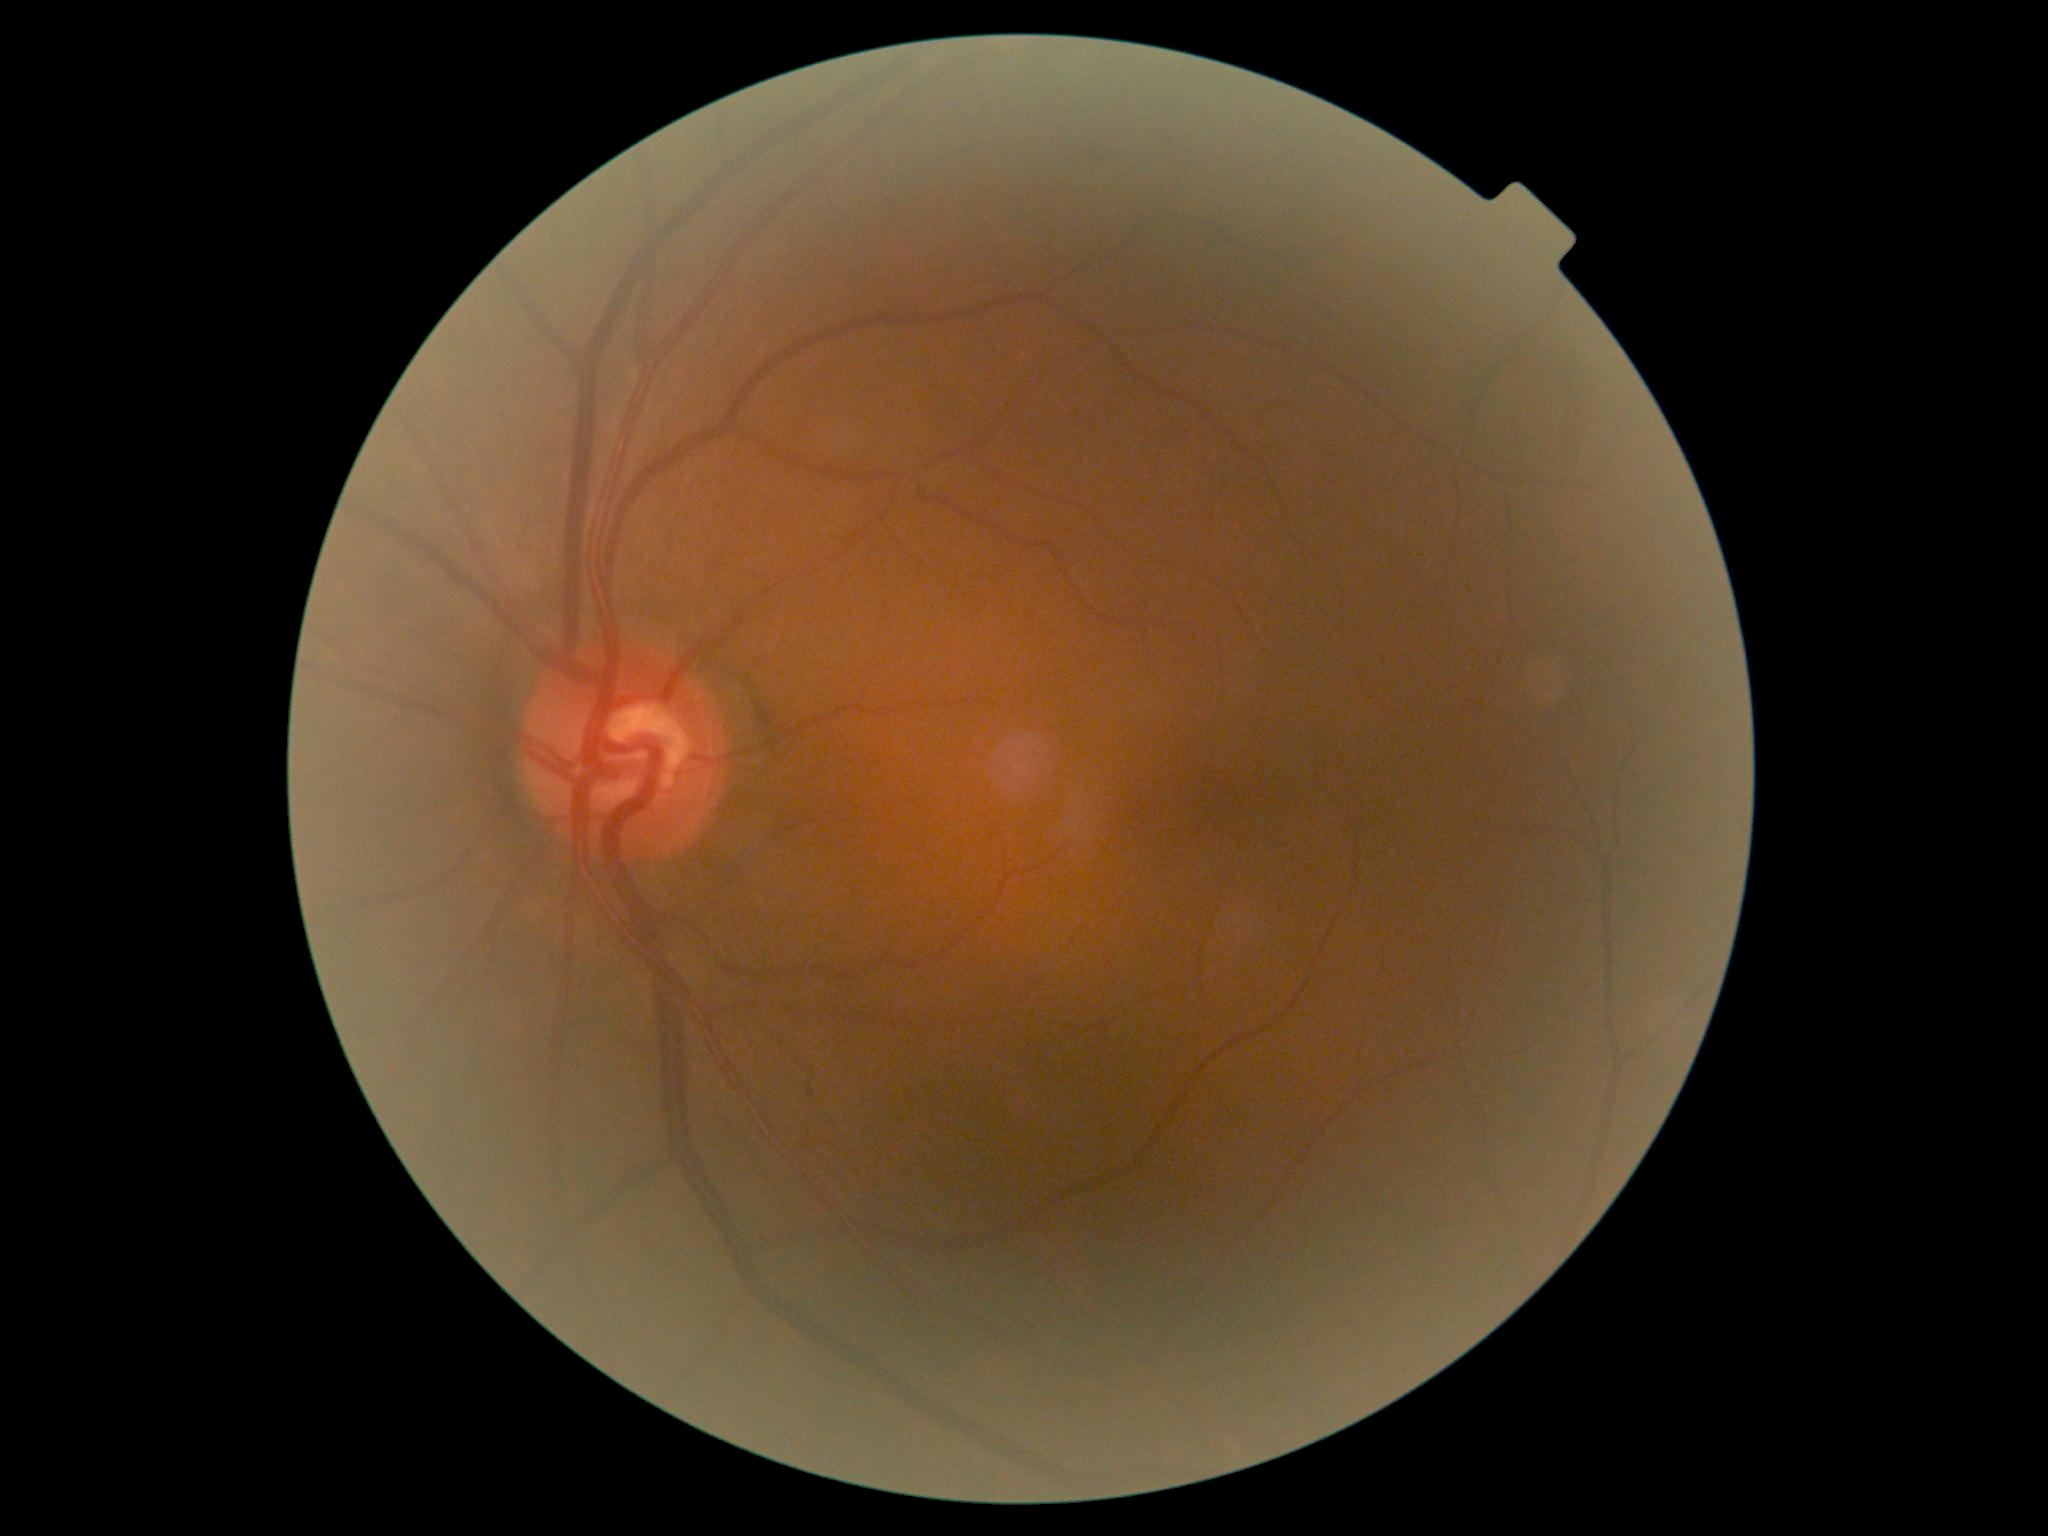
DR grade = 1
DR class = non-proliferative diabetic retinopathy